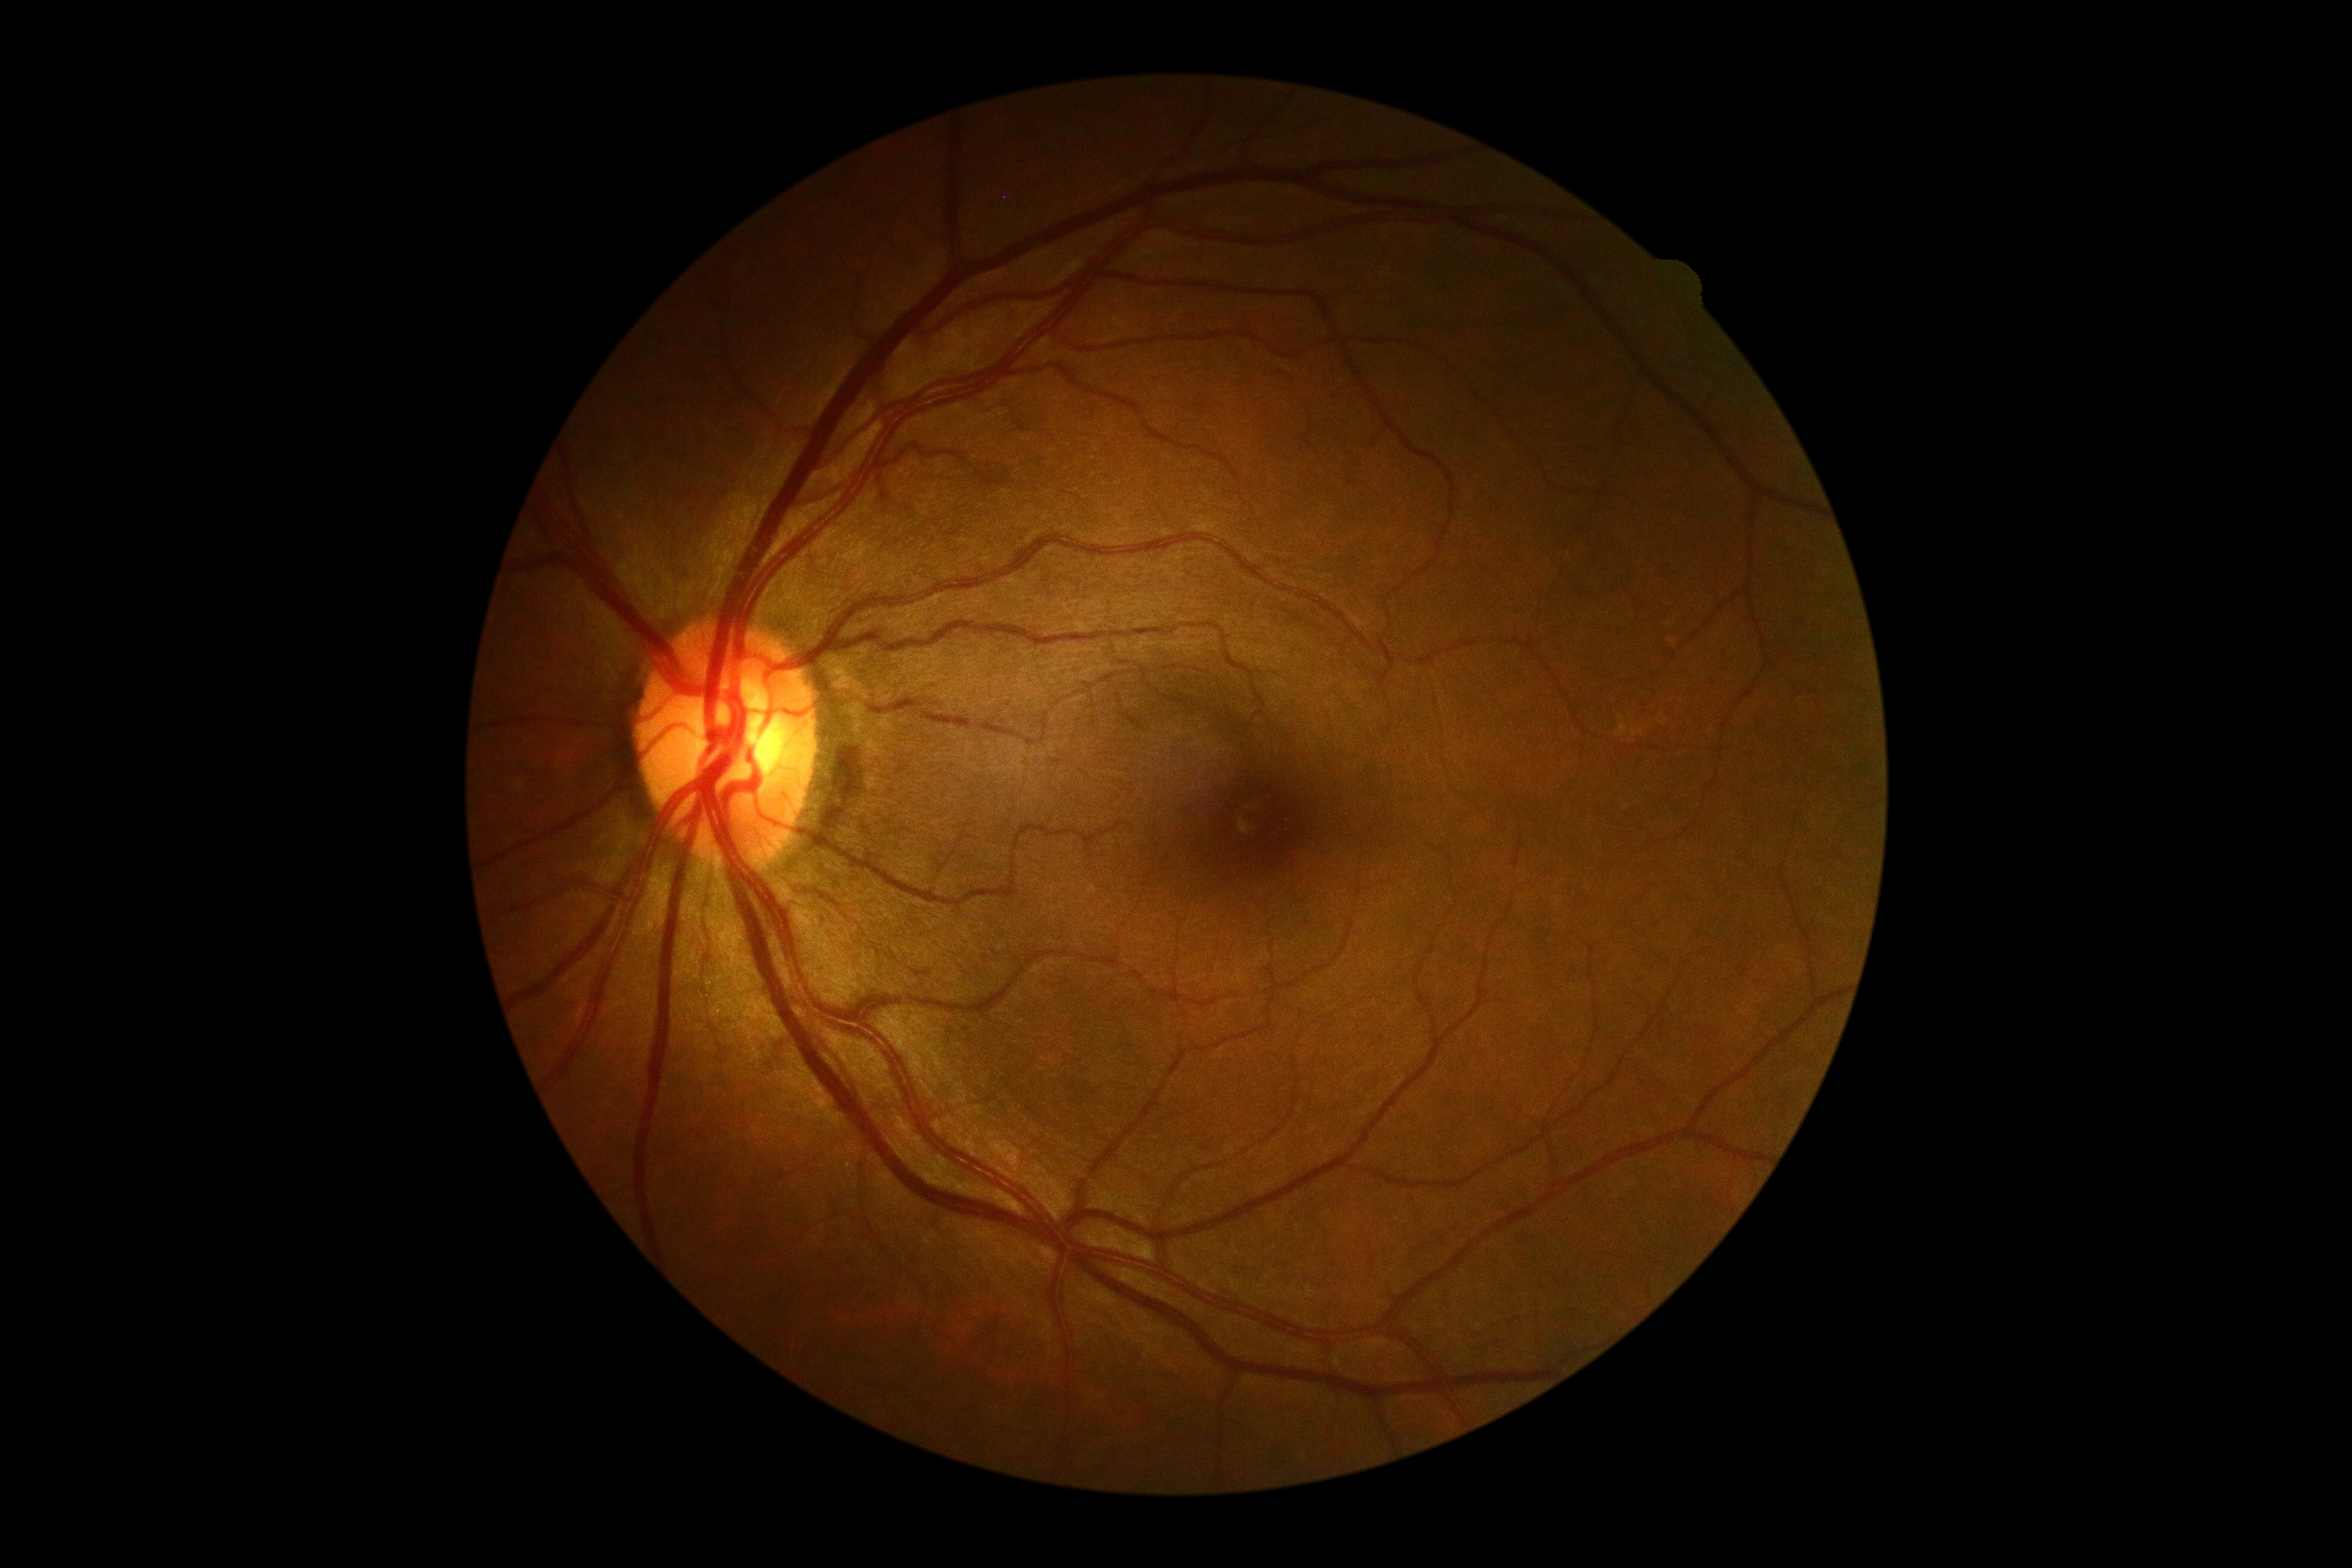 Diabetic retinopathy grade: 0 — no visible signs of diabetic retinopathy. No signs of diabetic retinopathy.